Mydriatic (tropicamide phenylephrine 1.0%), CFP
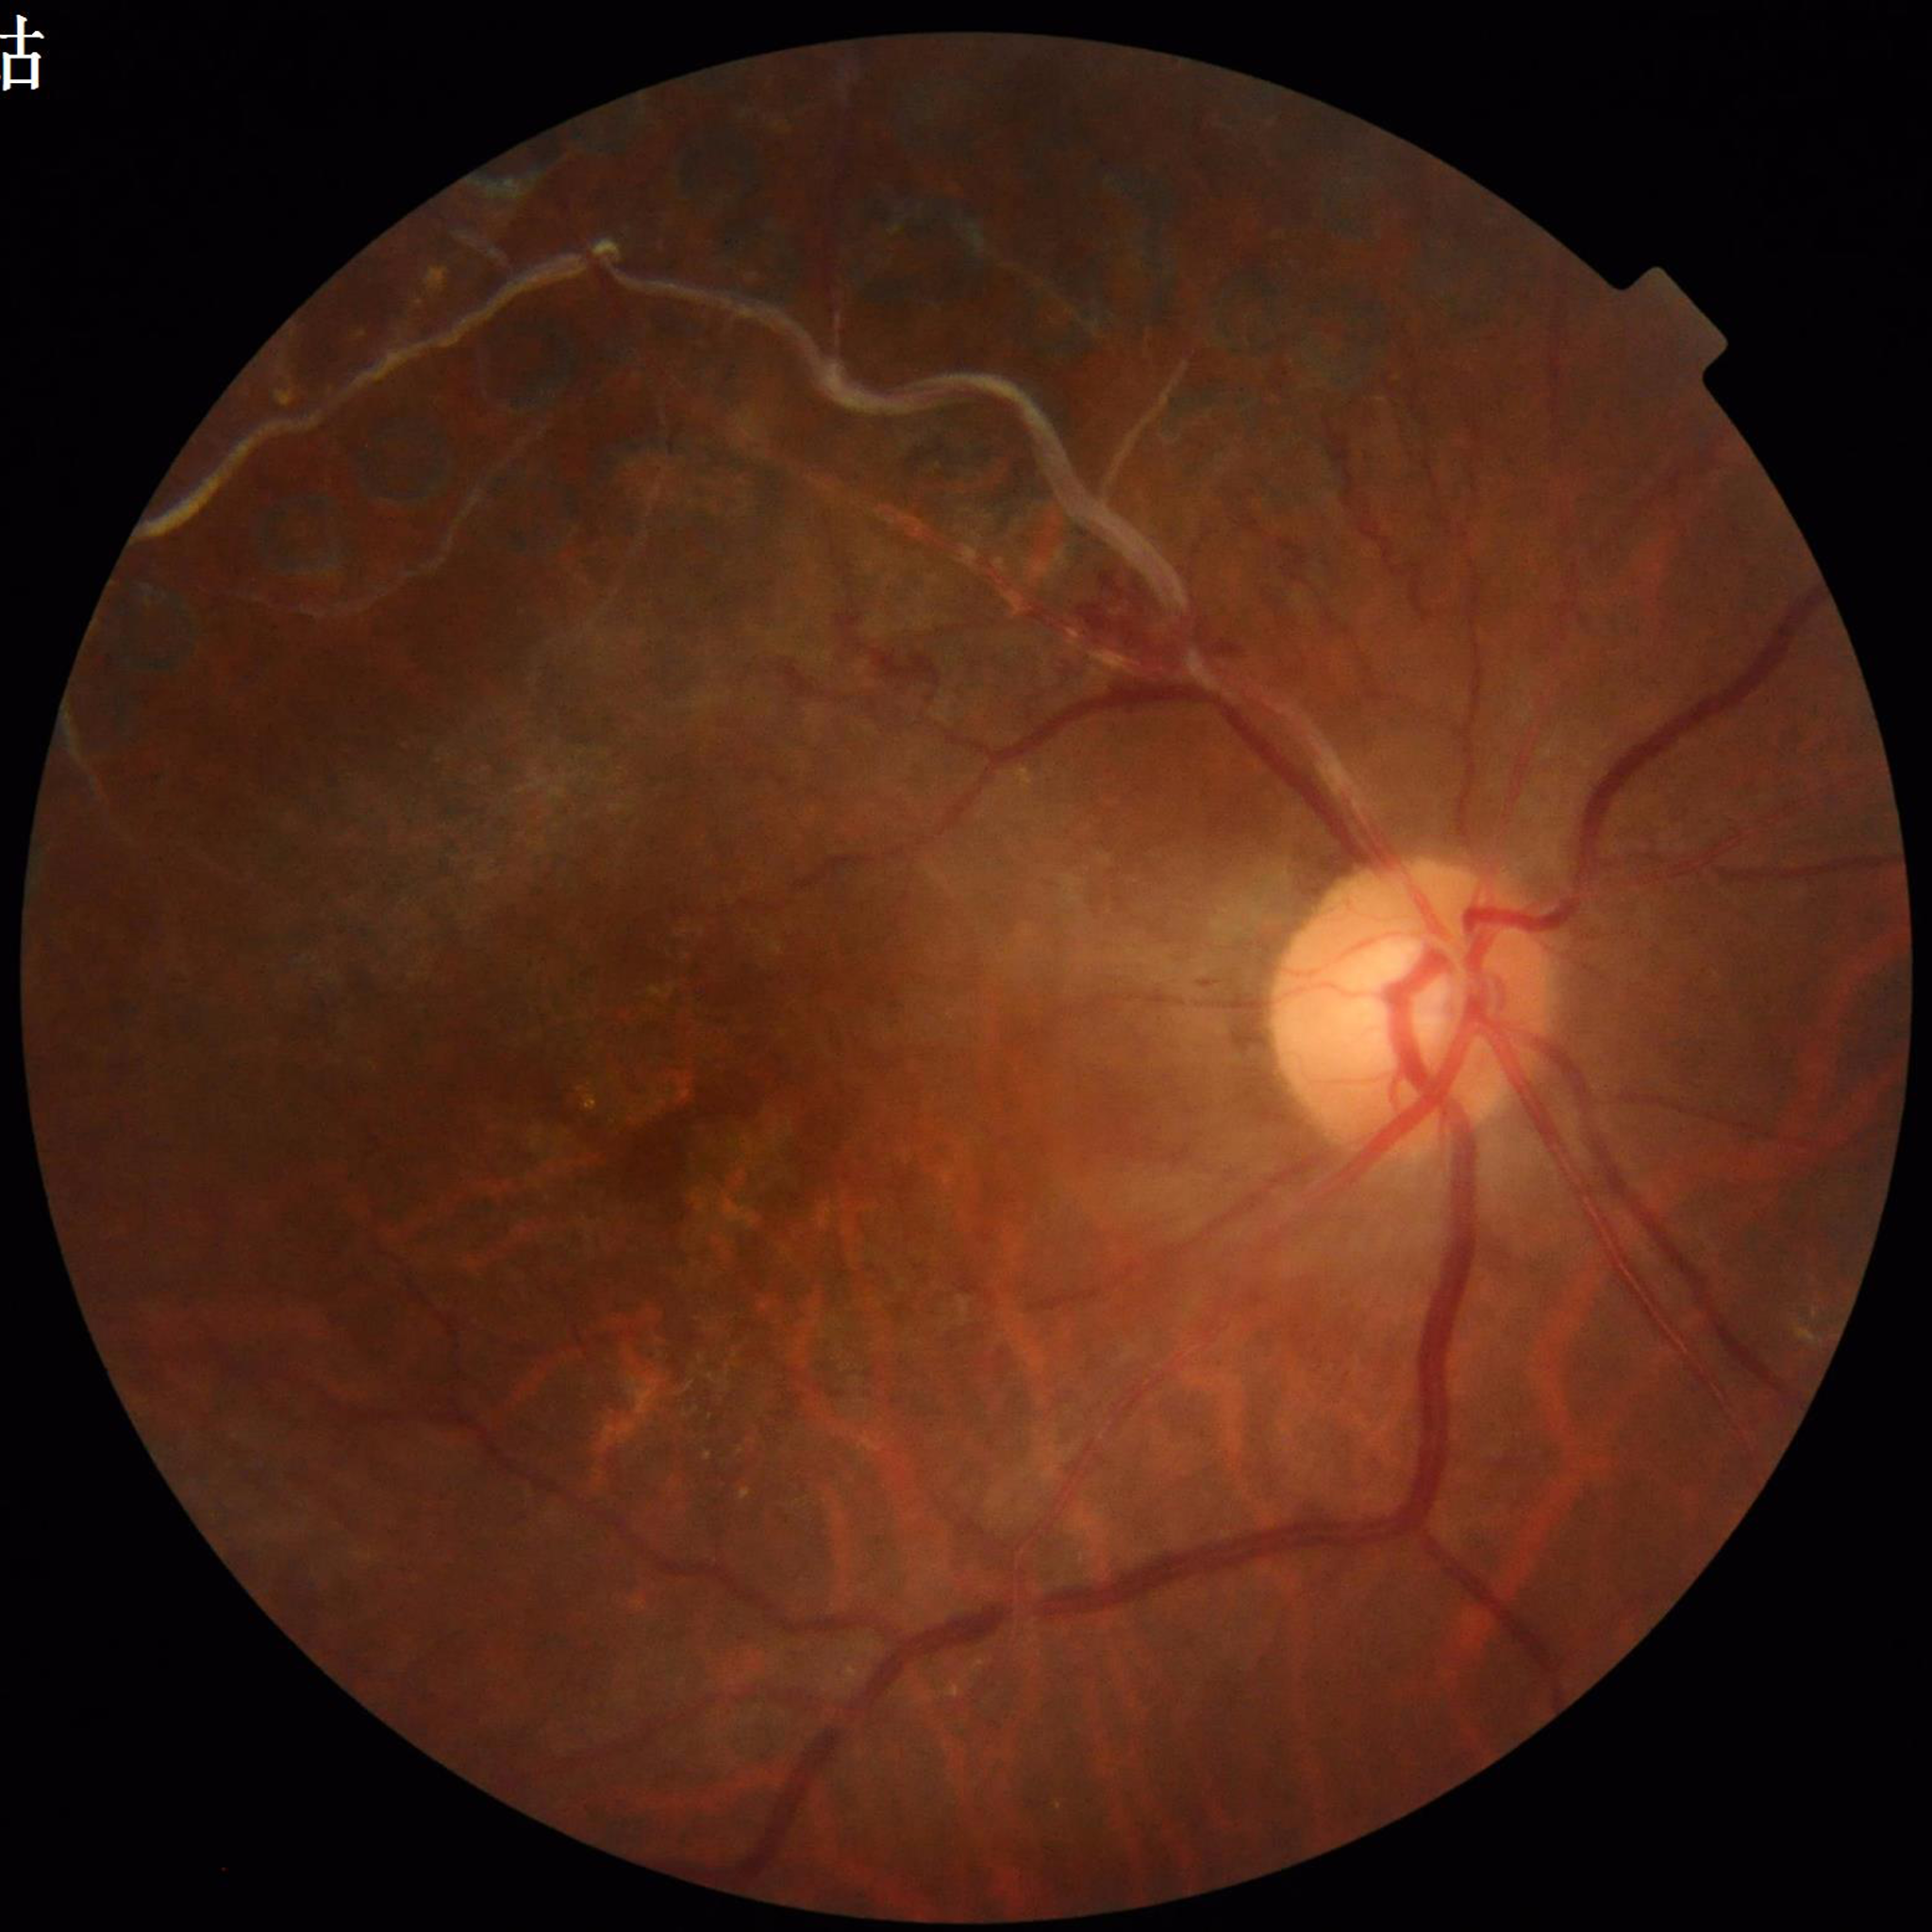
Eye affected by diabetic retinopathy.